Wide-field fundus photograph of an infant · 640 x 480 pixels
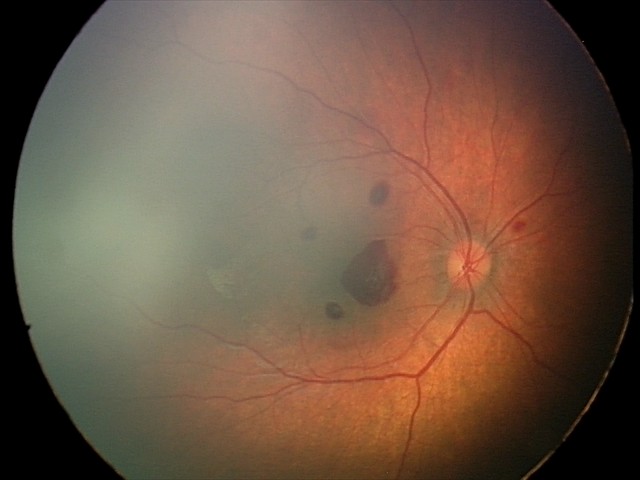 Screening diagnosis: retinal hemorrhages